848x848 · color fundus photograph: 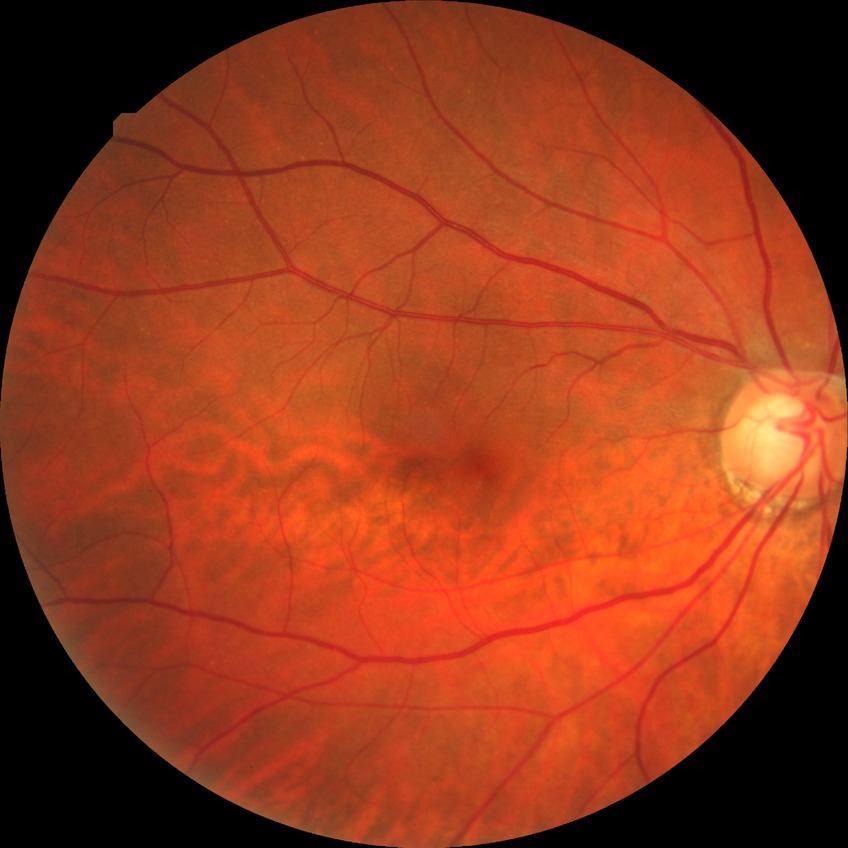 Davis DR grade@NDR.